Image size 640x480; wide-field fundus photograph of an infant; captured with the Clarity RetCam 3 (130° field of view).
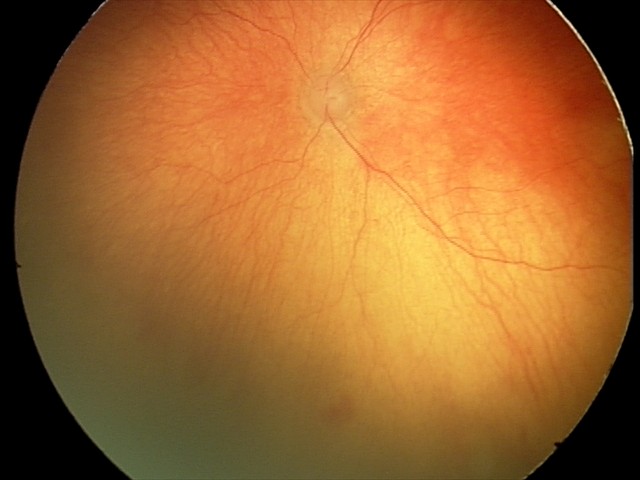

With plus disease. Examination diagnosed as aggressive retinopathy of prematurity (A-ROP).